Color fundus photograph
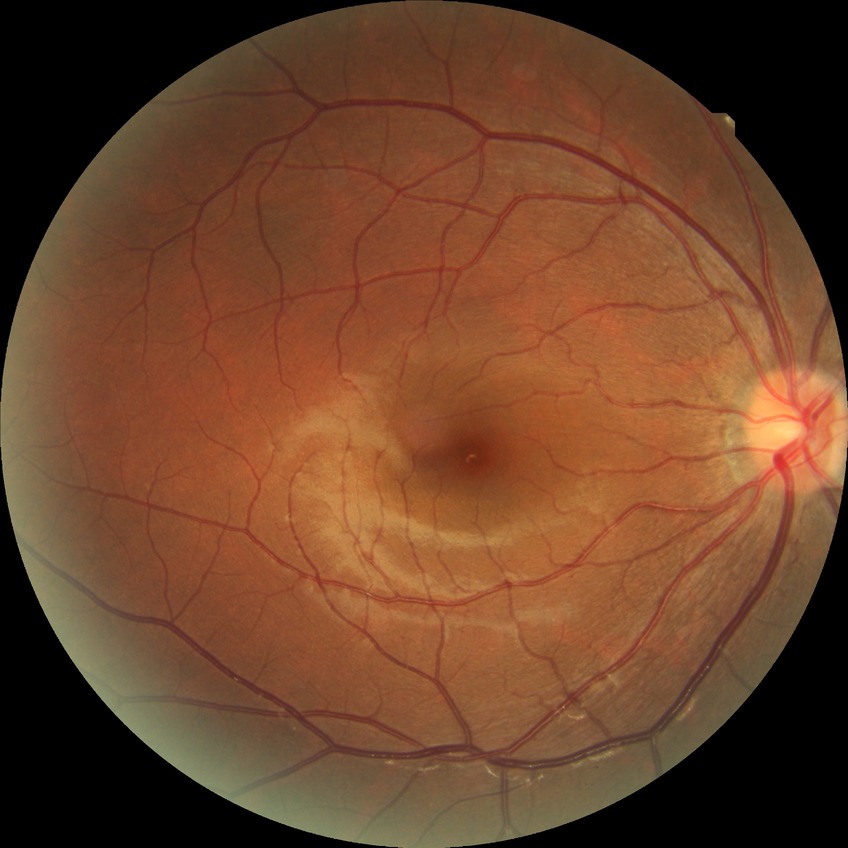

retinopathy stage: no diabetic retinopathy.